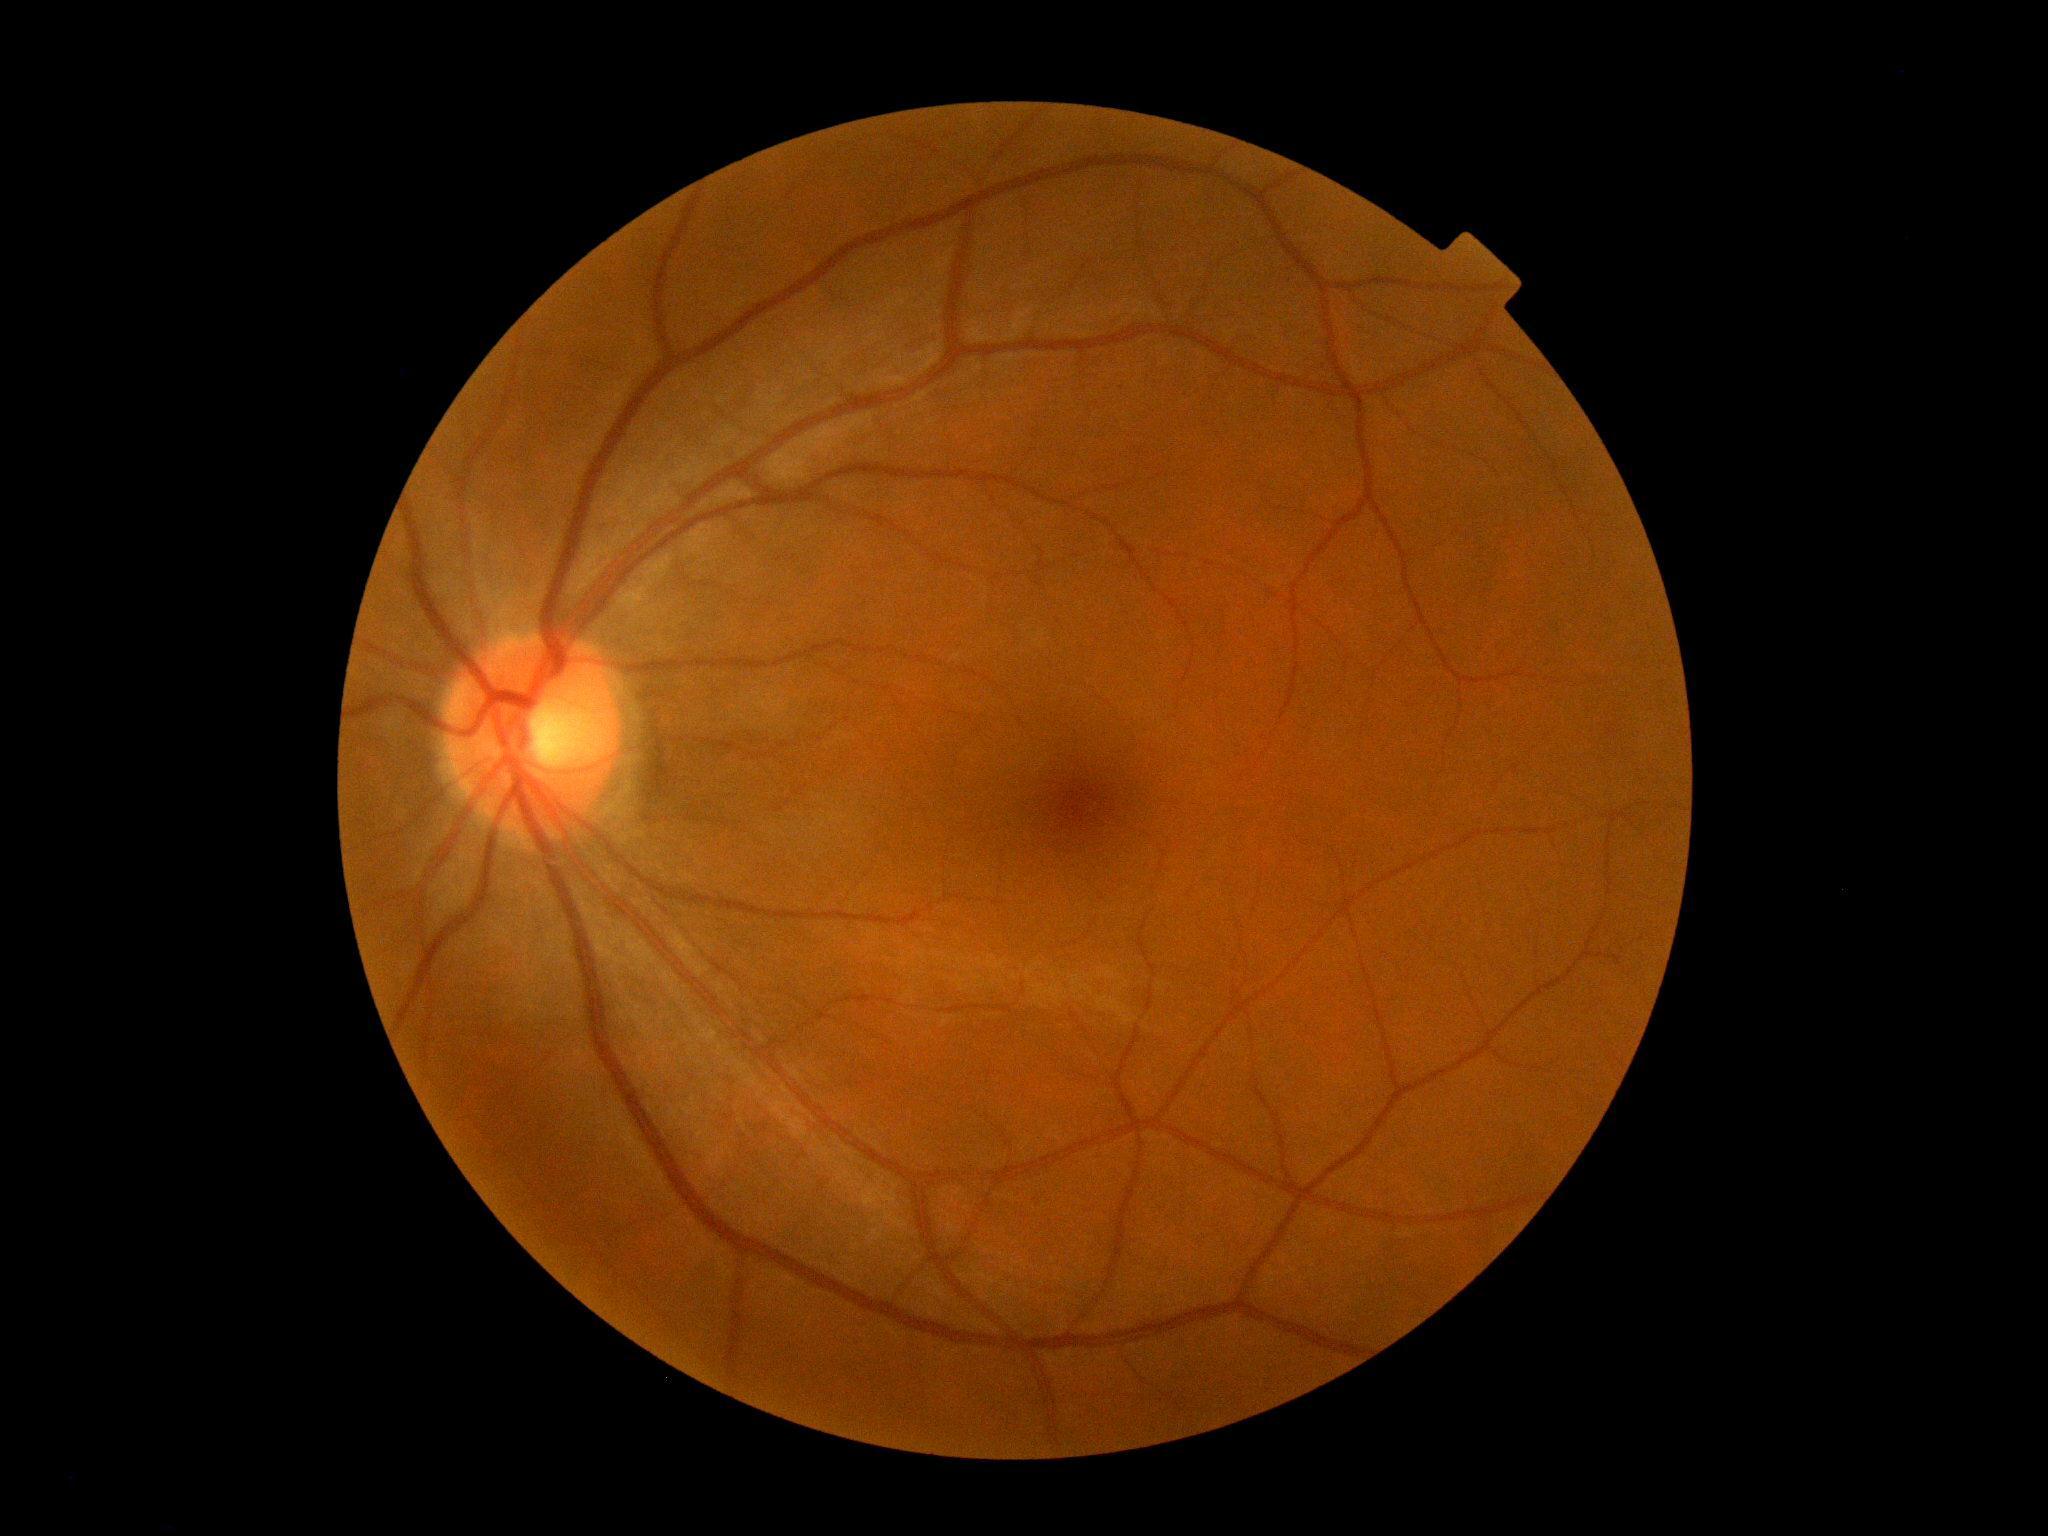
{
  "dr_grade": "no apparent diabetic retinopathy (0)",
  "dr_impression": "negative for DR"
}